DR severity per modified Davis staging:
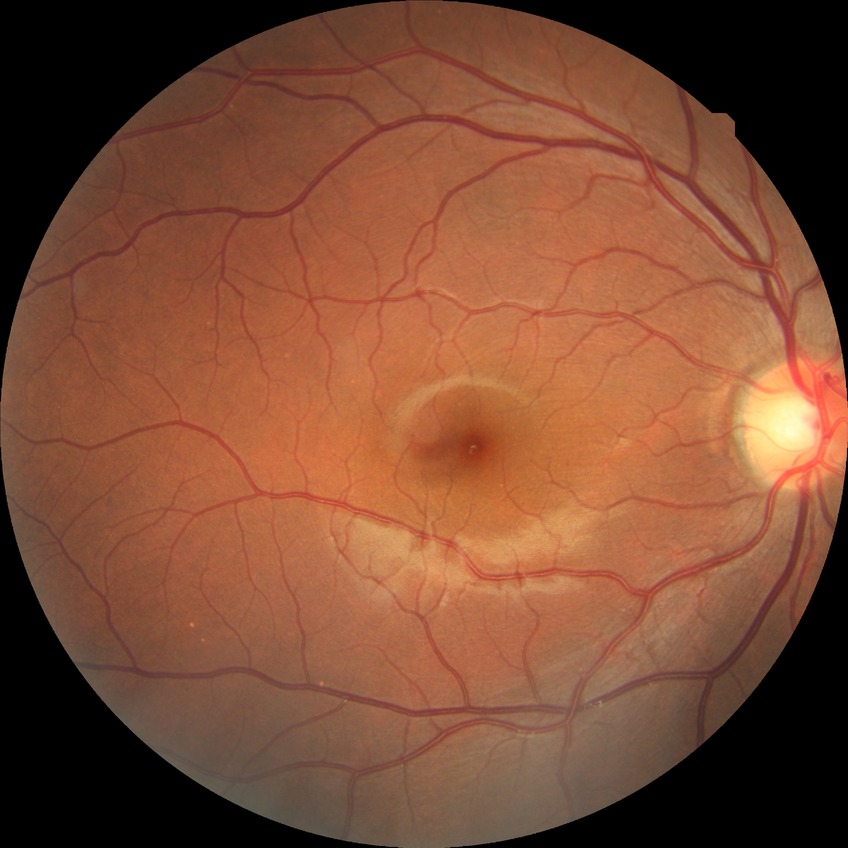
  davis_grade: NDR (no diabetic retinopathy)